FOV: 45 degrees.
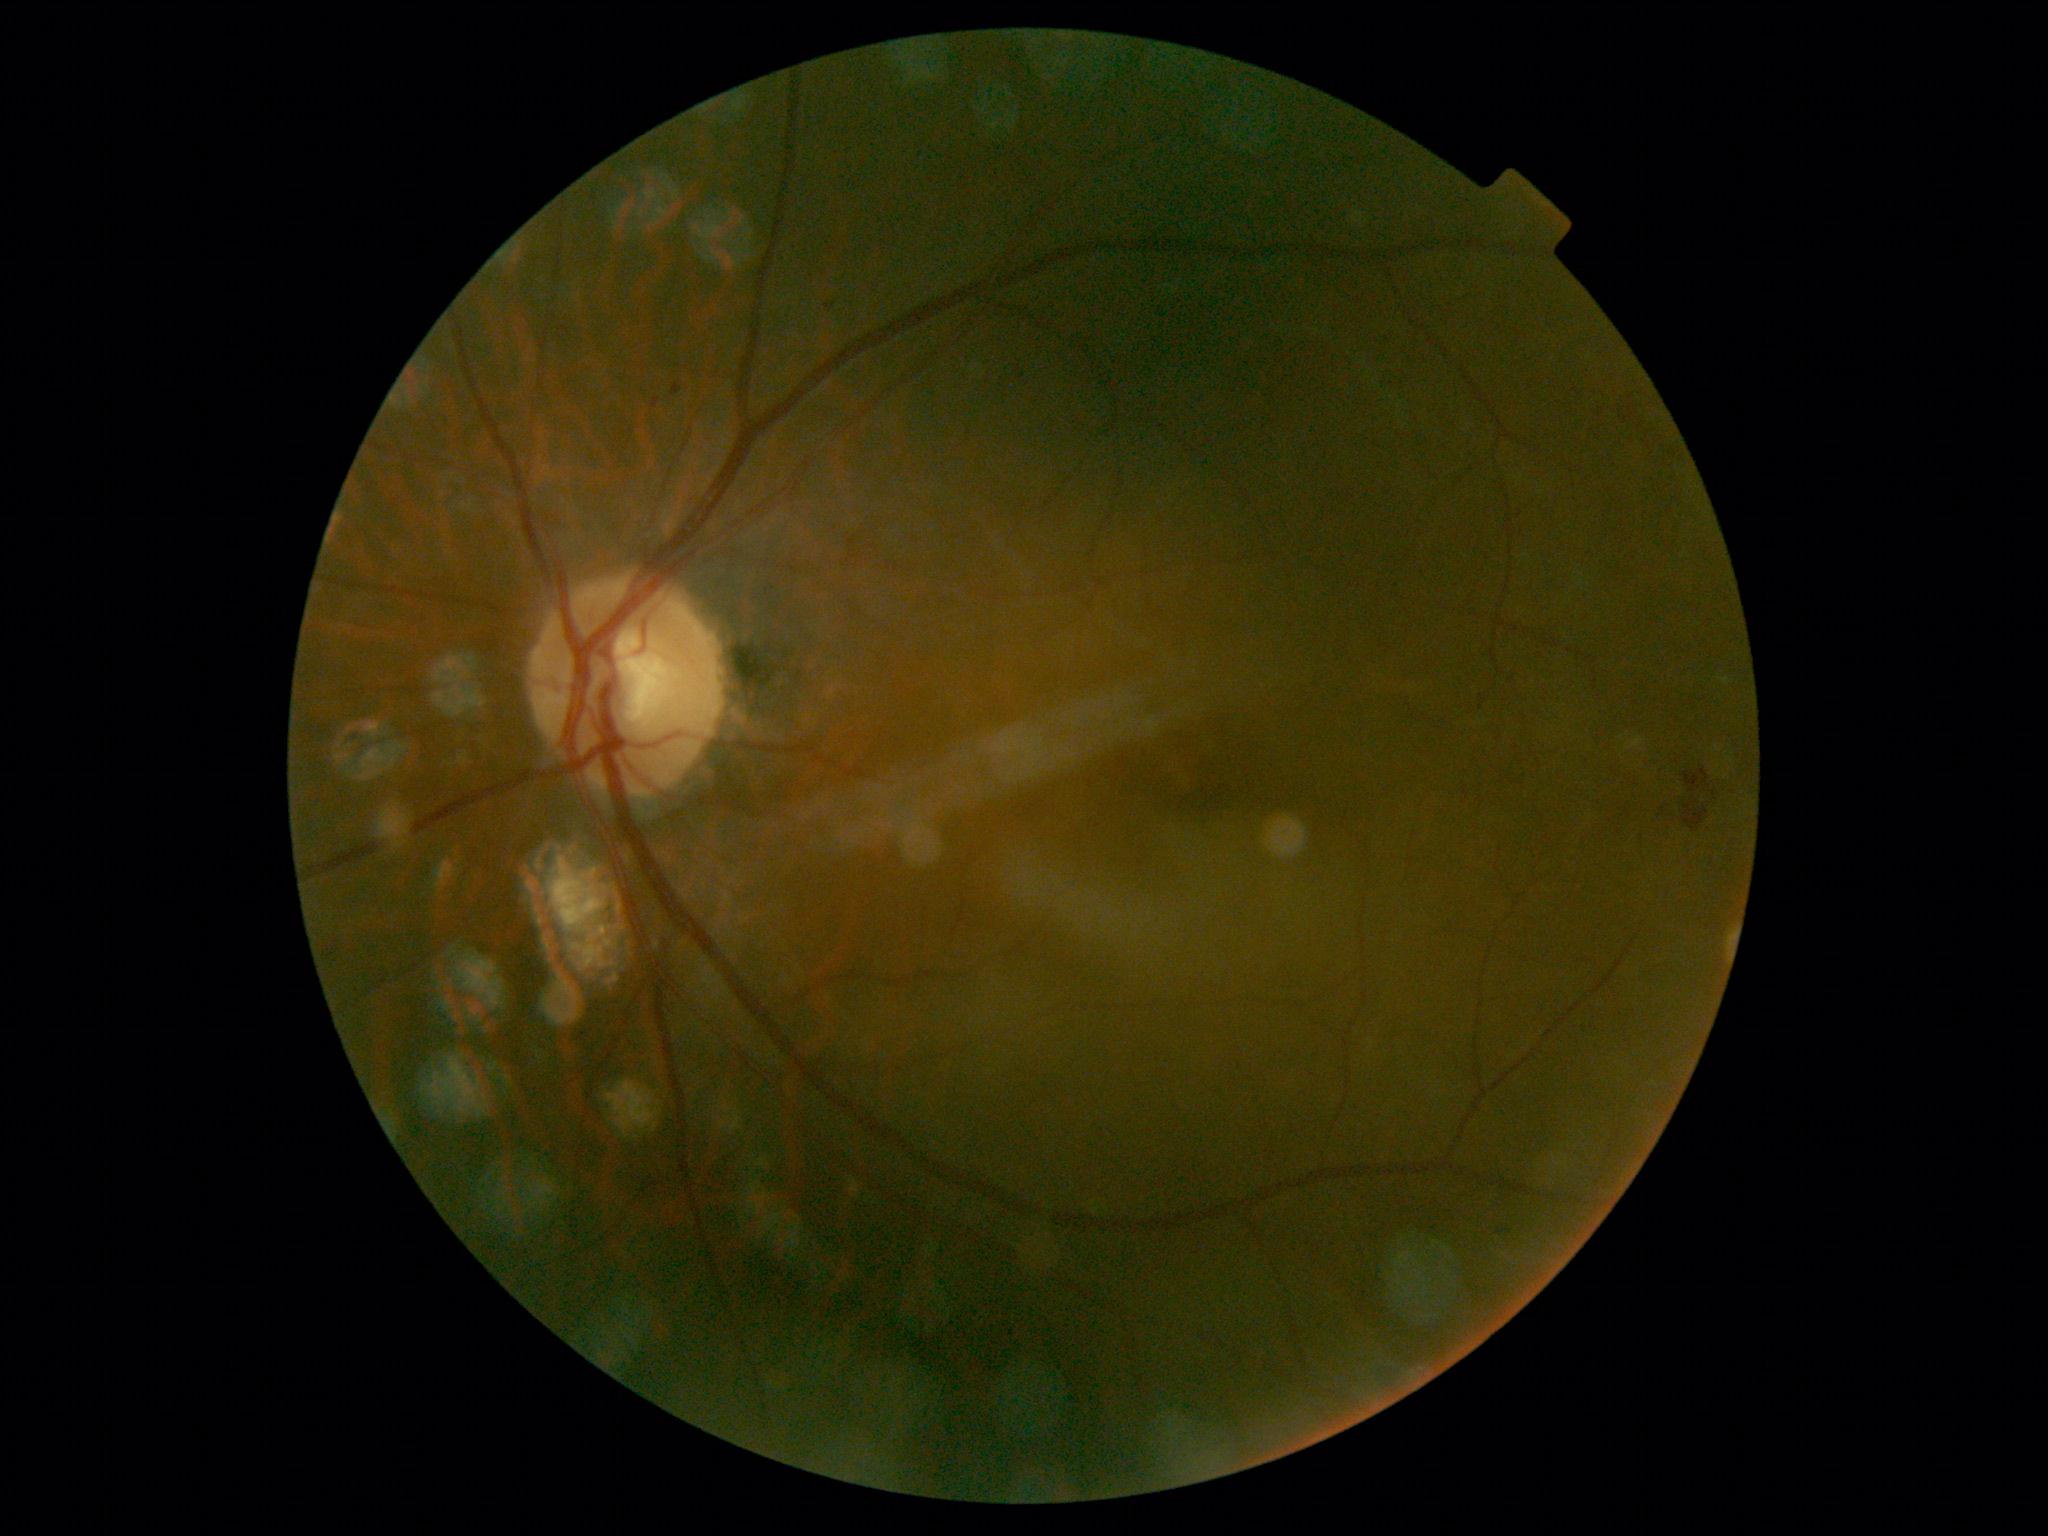
Retinopathy grade is 2/4.